Pediatric wide-field fundus photograph; 640x480; acquired on the Clarity RetCam 3:
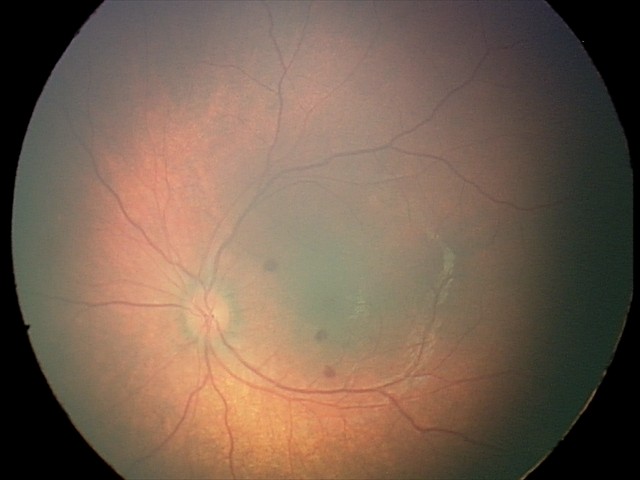

Examination diagnosed as retinal hemorrhages.